848x848px; nonmydriatic fundus photograph
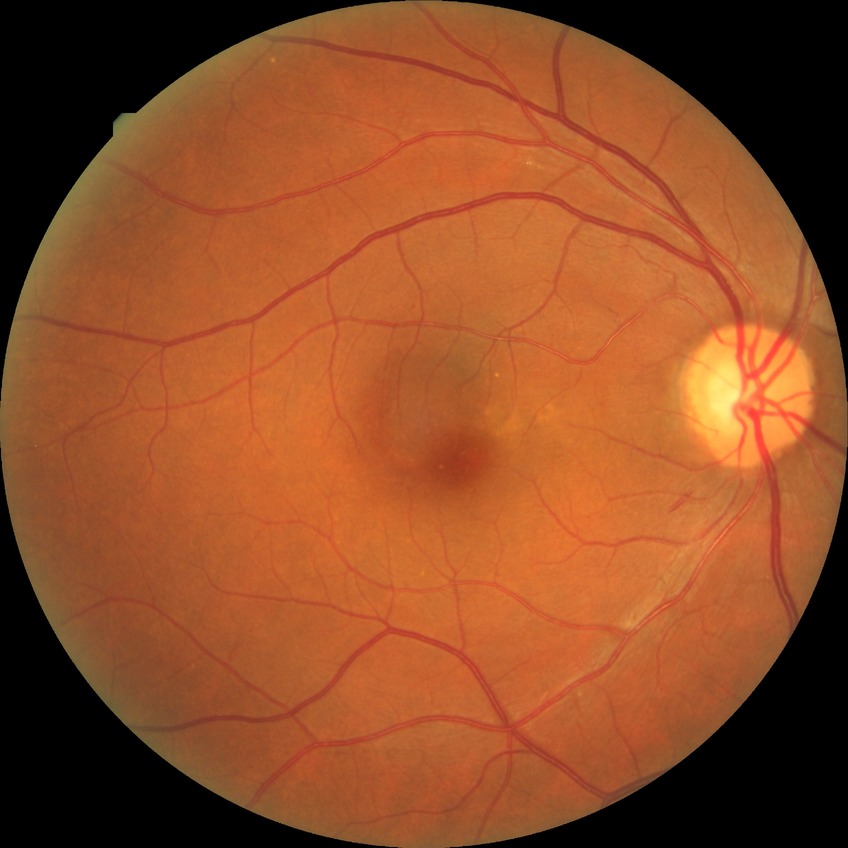
Modified Davis classification is no diabetic retinopathy.